848x848px · 45 degree fundus photograph: 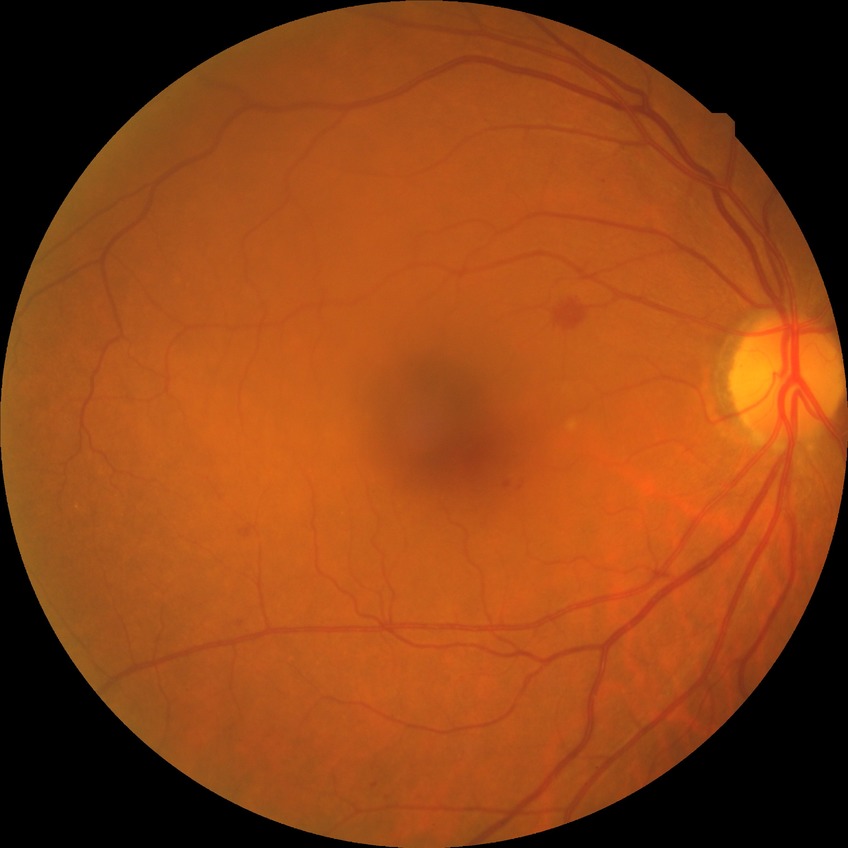 modified Davis classification = simple diabetic retinopathy.